2048x1536px, FOV: 45 degrees, fundus photo: 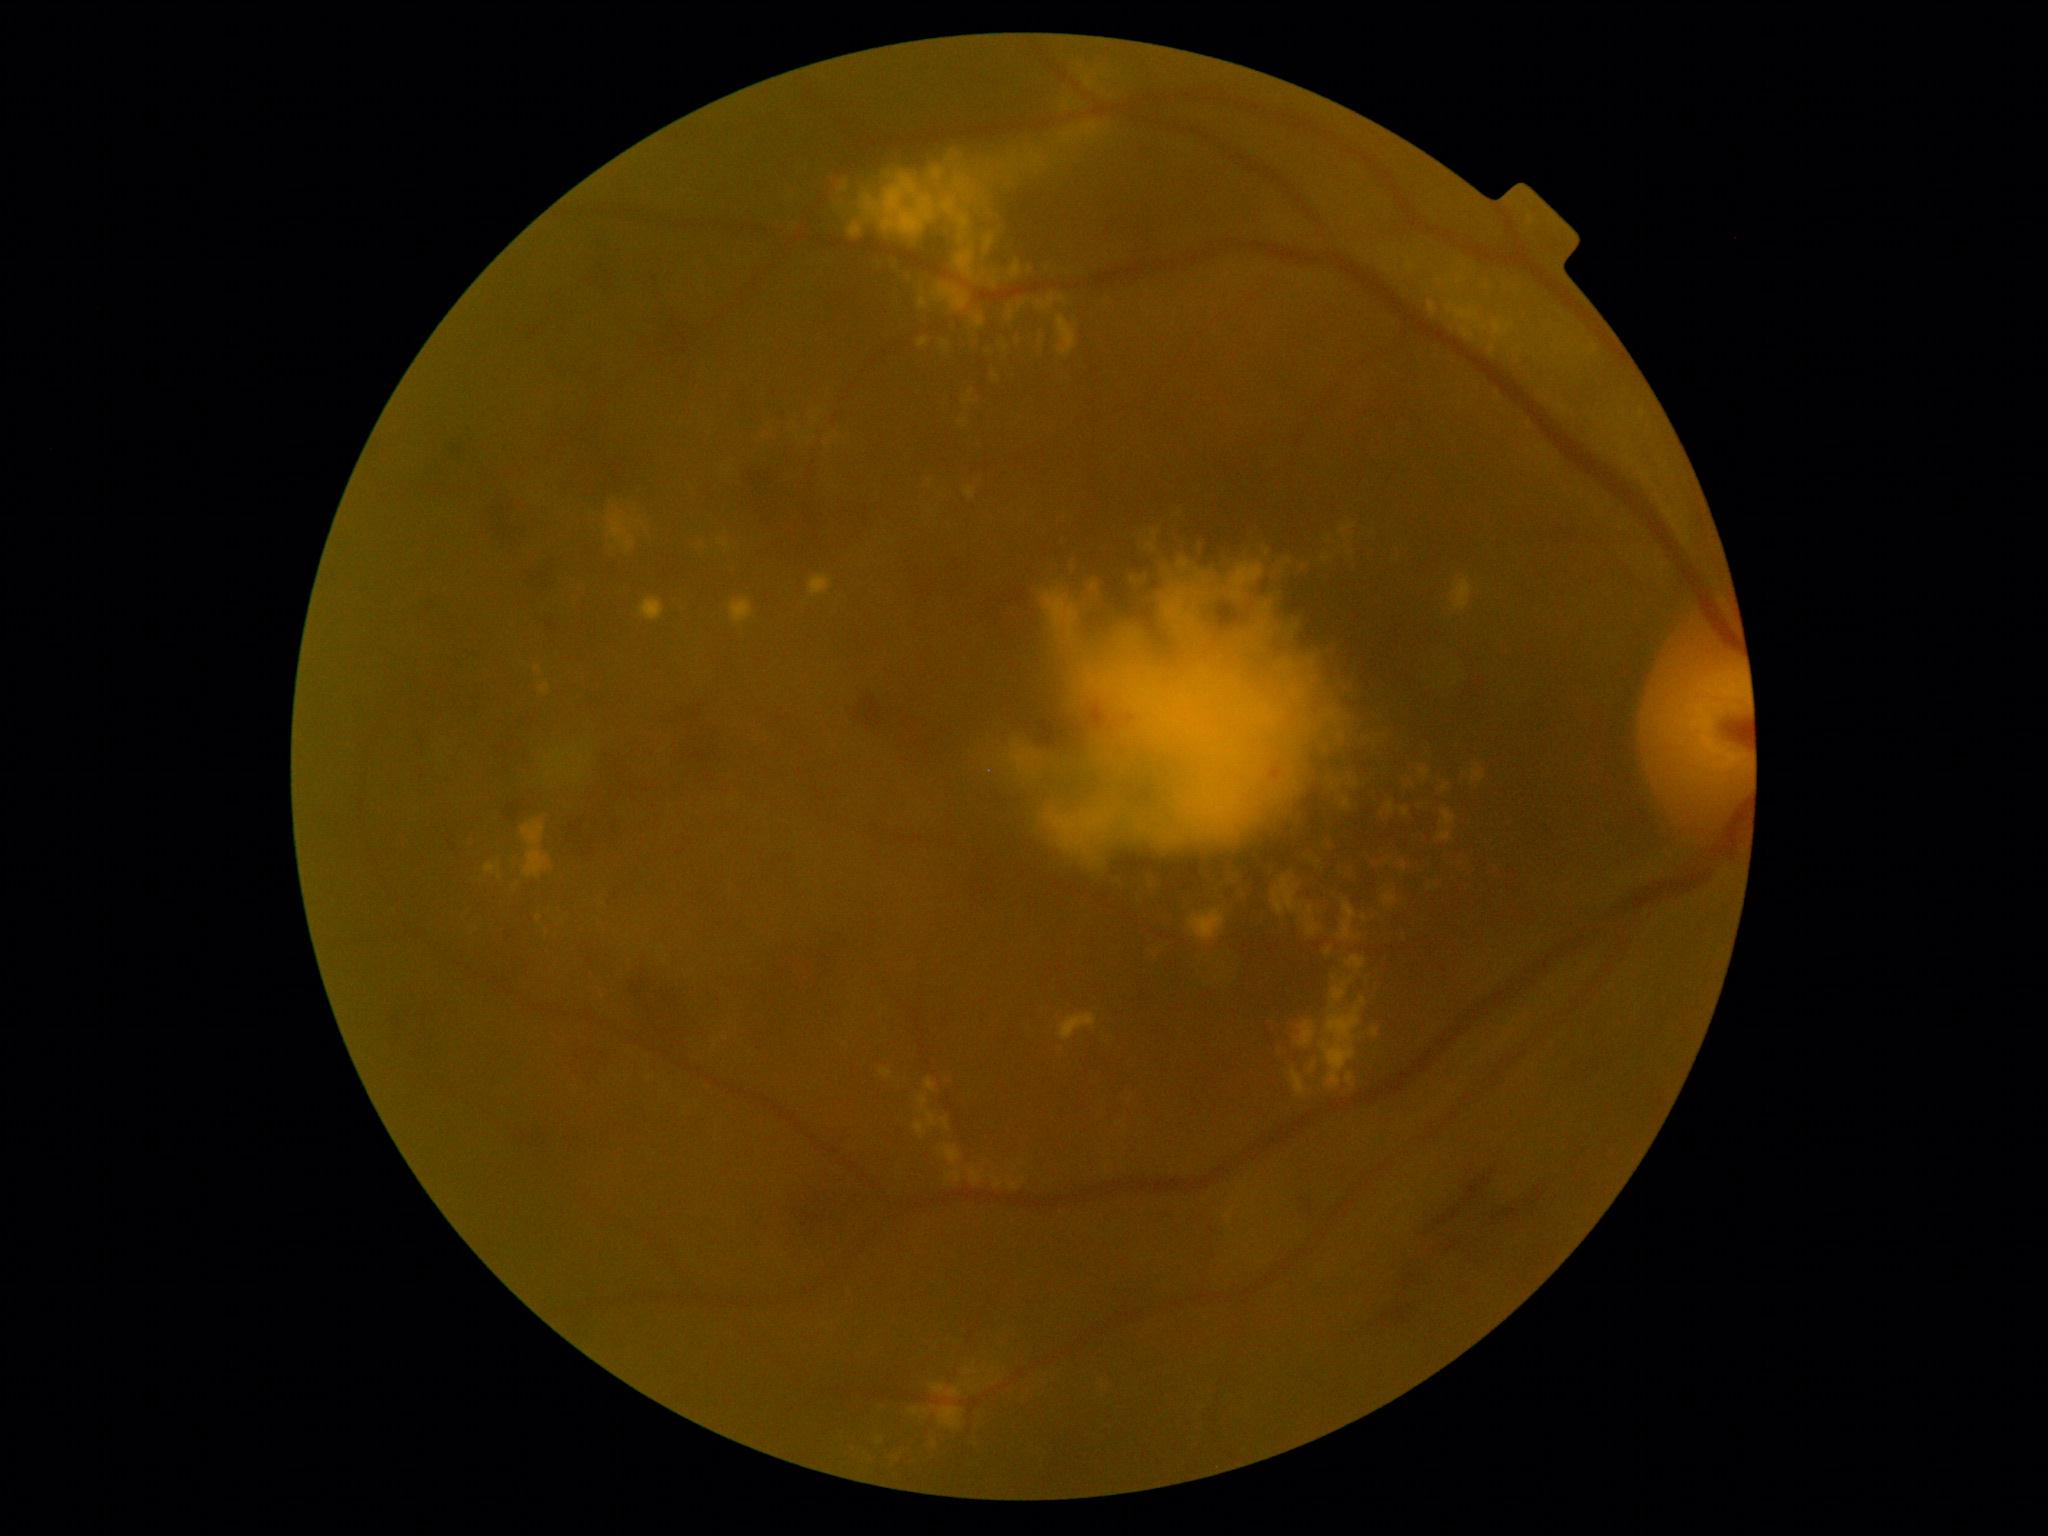 partial: true
dr_grade: 2
lesions:
  ma: []
  se: []
  he:
    - (x1=543, y1=614, x2=562, y2=628)
    - (x1=848, y1=688, x2=888, y2=738)
    - (x1=424, y1=683, x2=485, y2=723)
    - (x1=548, y1=353, x2=609, y2=381)
    - (x1=492, y1=711, x2=538, y2=770)
    - (x1=579, y1=452, x2=647, y2=510)
    - (x1=756, y1=939, x2=858, y2=1042)
    - (x1=789, y1=1178, x2=876, y2=1262)
    - (x1=630, y1=958, x2=737, y2=1061)
    - (x1=607, y1=869, x2=644, y2=909)
    - (x1=574, y1=1041, x2=611, y2=1087)
    - (x1=449, y1=436, x2=470, y2=466)
    - (x1=419, y1=594, x2=444, y2=611)
    - (x1=526, y1=553, x2=555, y2=594)
    - (x1=1301, y1=1187, x2=1320, y2=1223)
    - (x1=566, y1=703, x2=729, y2=849)
  ex:
    - (x1=971, y1=1170, x2=982, y2=1184)
    - (x1=522, y1=820, x2=549, y2=879)
    - (x1=1345, y1=956, x2=1367, y2=971)
    - (x1=994, y1=232, x2=1011, y2=260)
    - (x1=978, y1=265, x2=1004, y2=294)
    - (x1=1189, y1=909, x2=1226, y2=942)
    - (x1=939, y1=1406, x2=964, y2=1429)
    - (x1=1043, y1=508, x2=1394, y2=876)
    - (x1=942, y1=1146, x2=962, y2=1164)
    - (x1=990, y1=337, x2=1023, y2=364)
    - (x1=947, y1=1386, x2=962, y2=1398)
    - (x1=942, y1=341, x2=949, y2=353)
    - (x1=962, y1=390, x2=975, y2=406)
    - (x1=1420, y1=768, x2=1430, y2=780)
    - (x1=1472, y1=764, x2=1486, y2=783)
    - (x1=1401, y1=809, x2=1409, y2=817)
  ex_small_approx:
    - 1030:270
    - 1314:1065